Color fundus image — 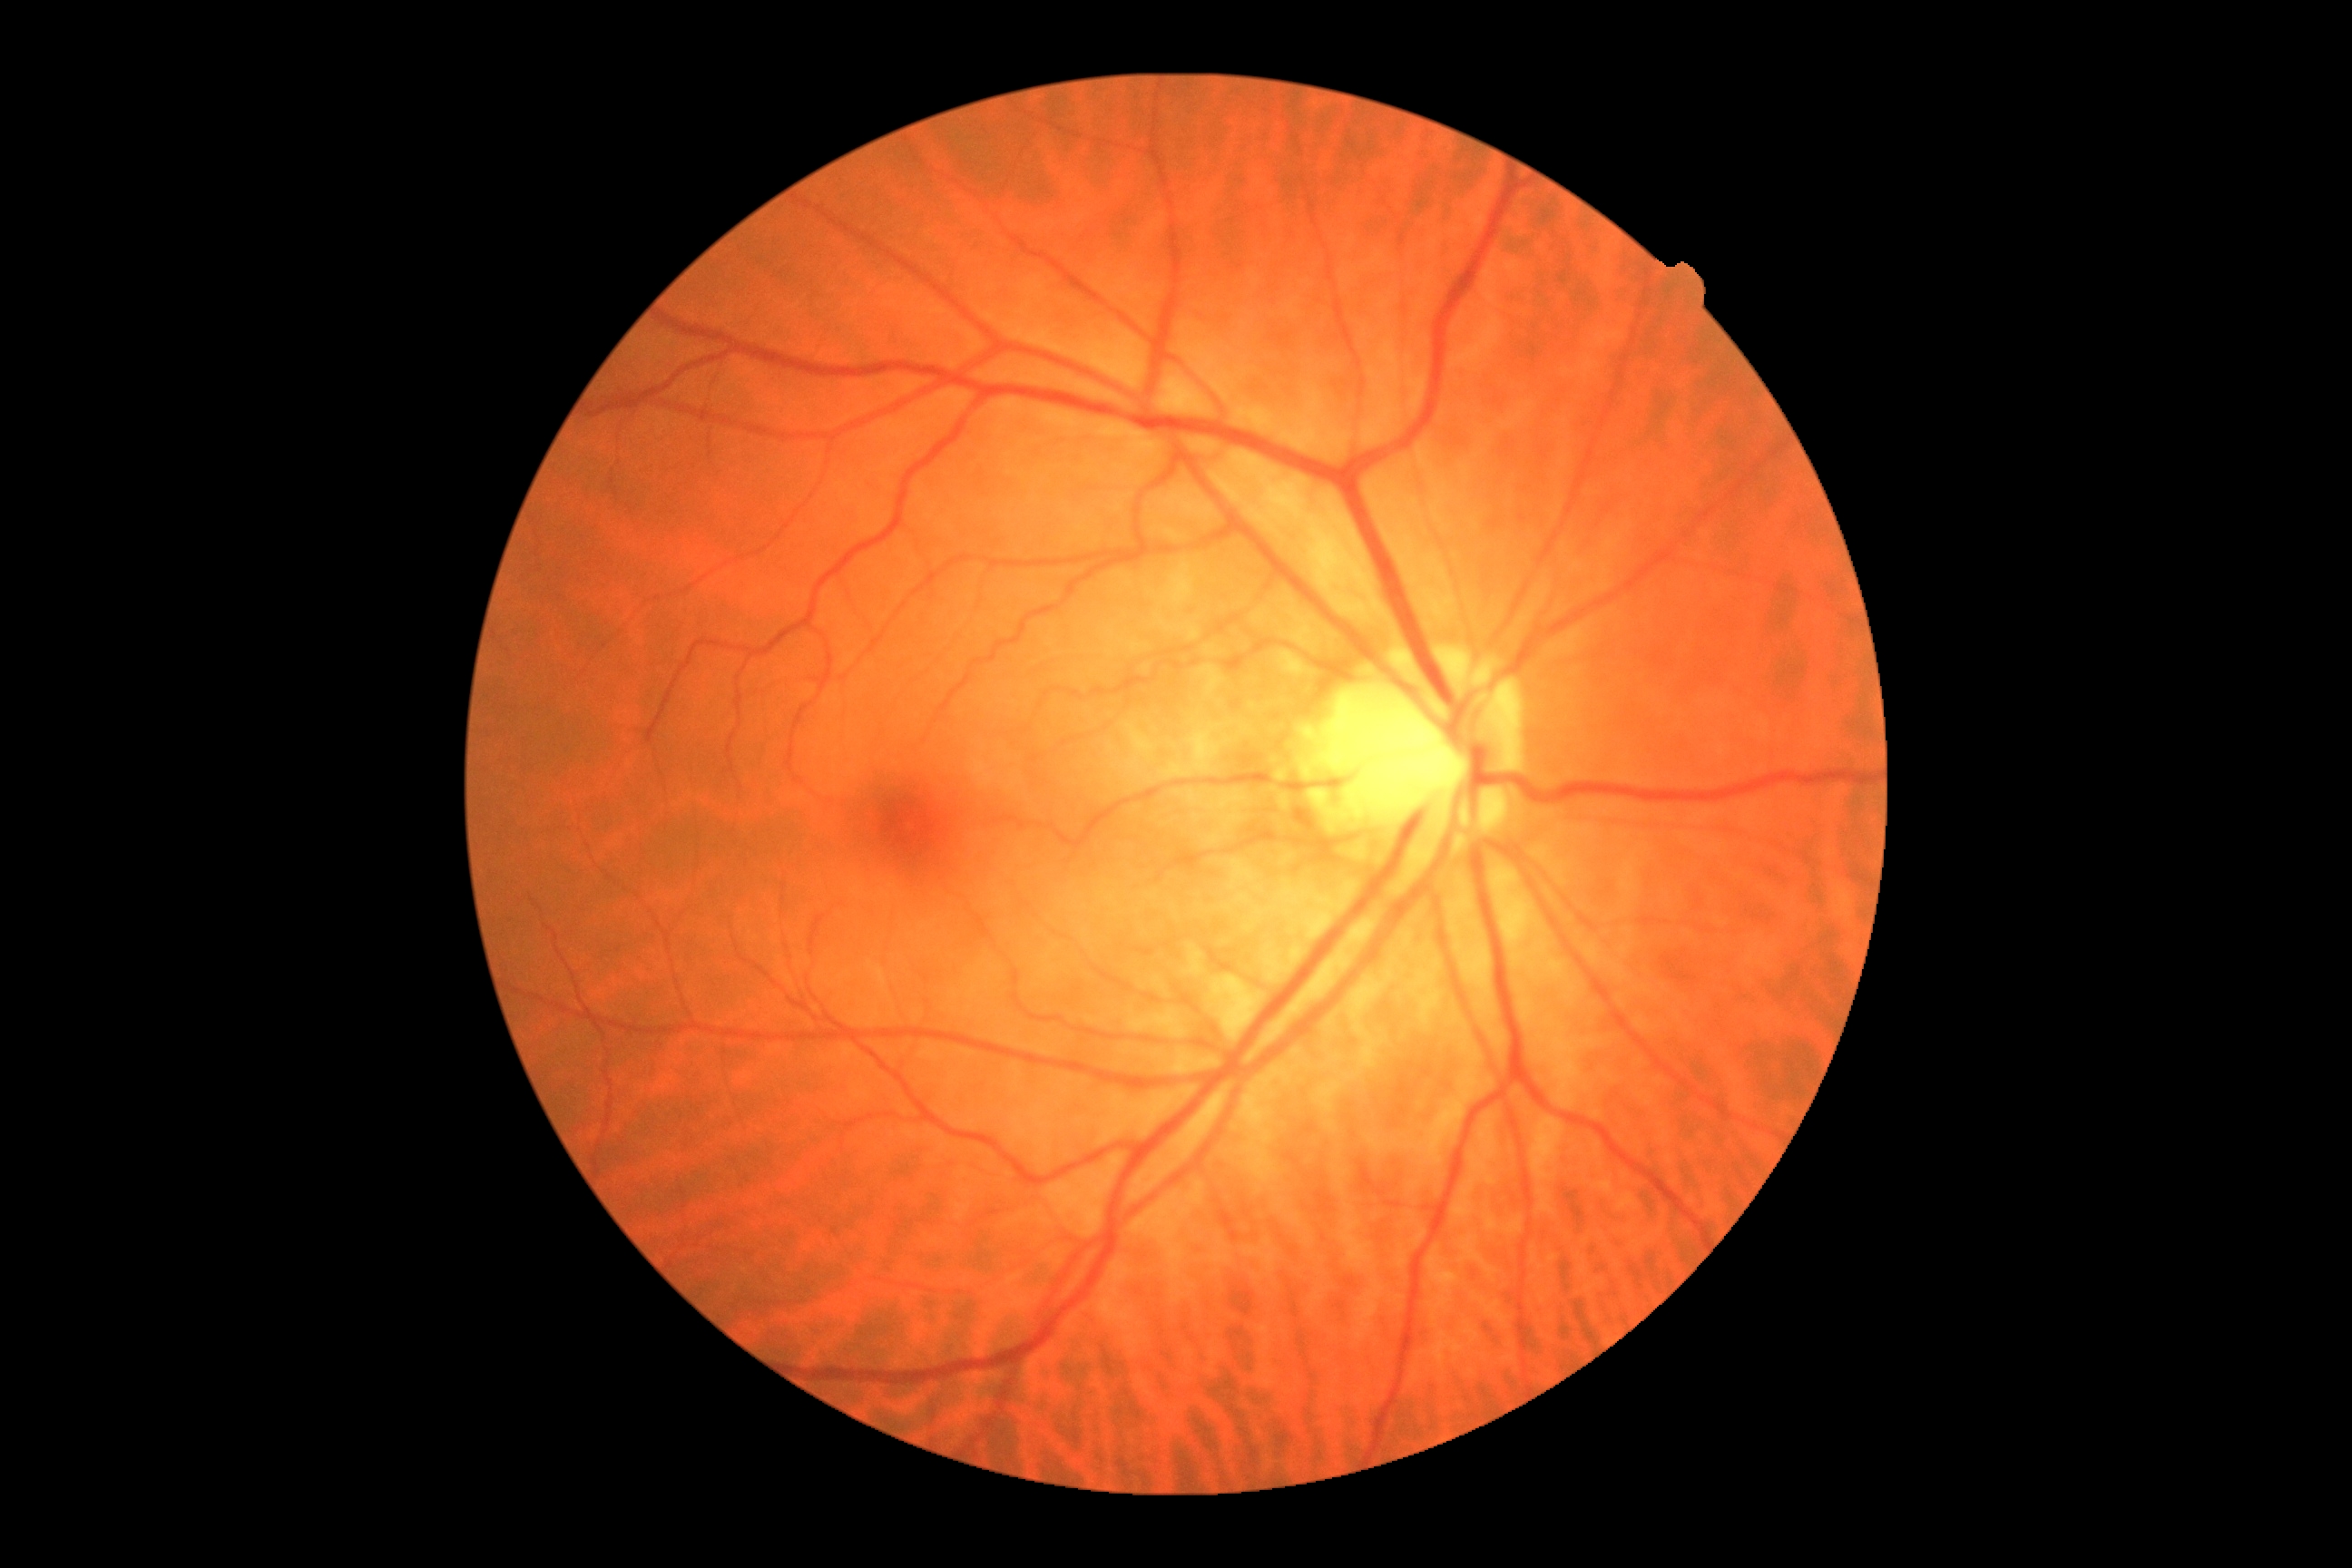

DR is no apparent diabetic retinopathy (grade 0).